Color fundus image; without pupil dilation; modified Davis grading; 848x848; FOV: 45 degrees; NIDEK AFC-230:
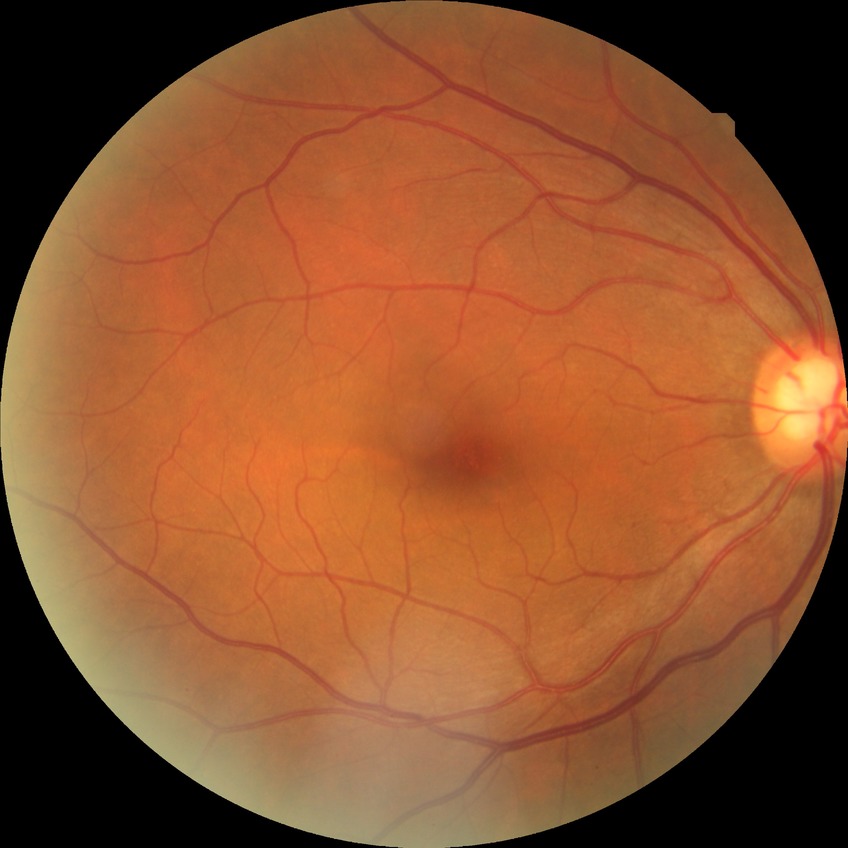
Modified Davis classification: no diabetic retinopathy.